Camera: NIDEK AFC-230 · nonmydriatic · posterior pole color fundus photograph · 45° FOV.
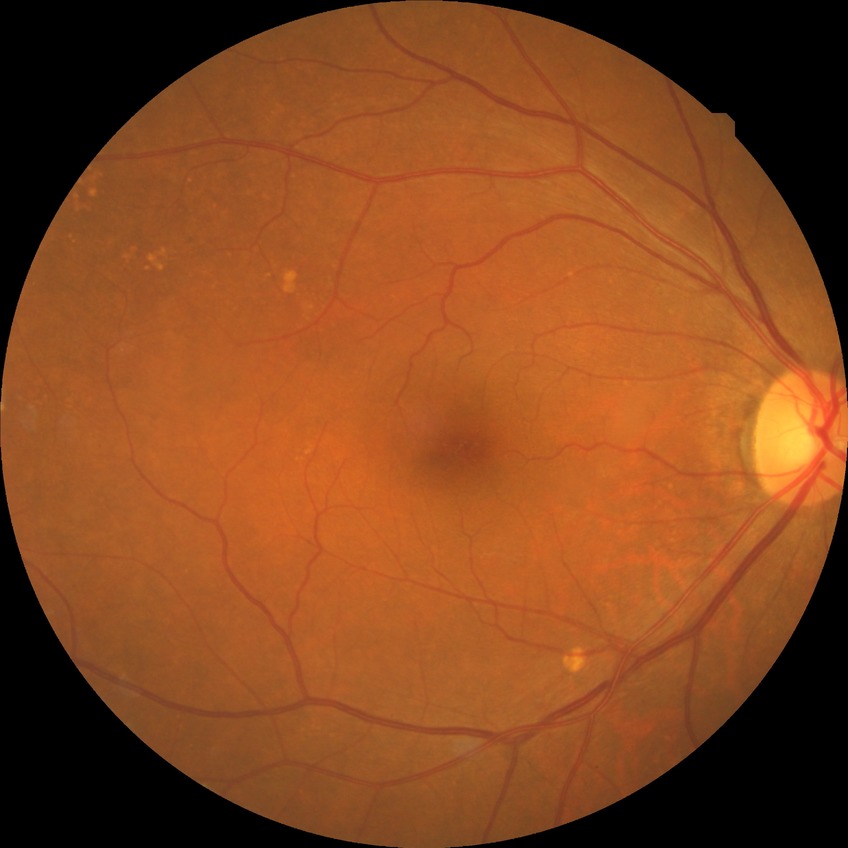 {
  "davis_grade": "NDR (no diabetic retinopathy)"
}